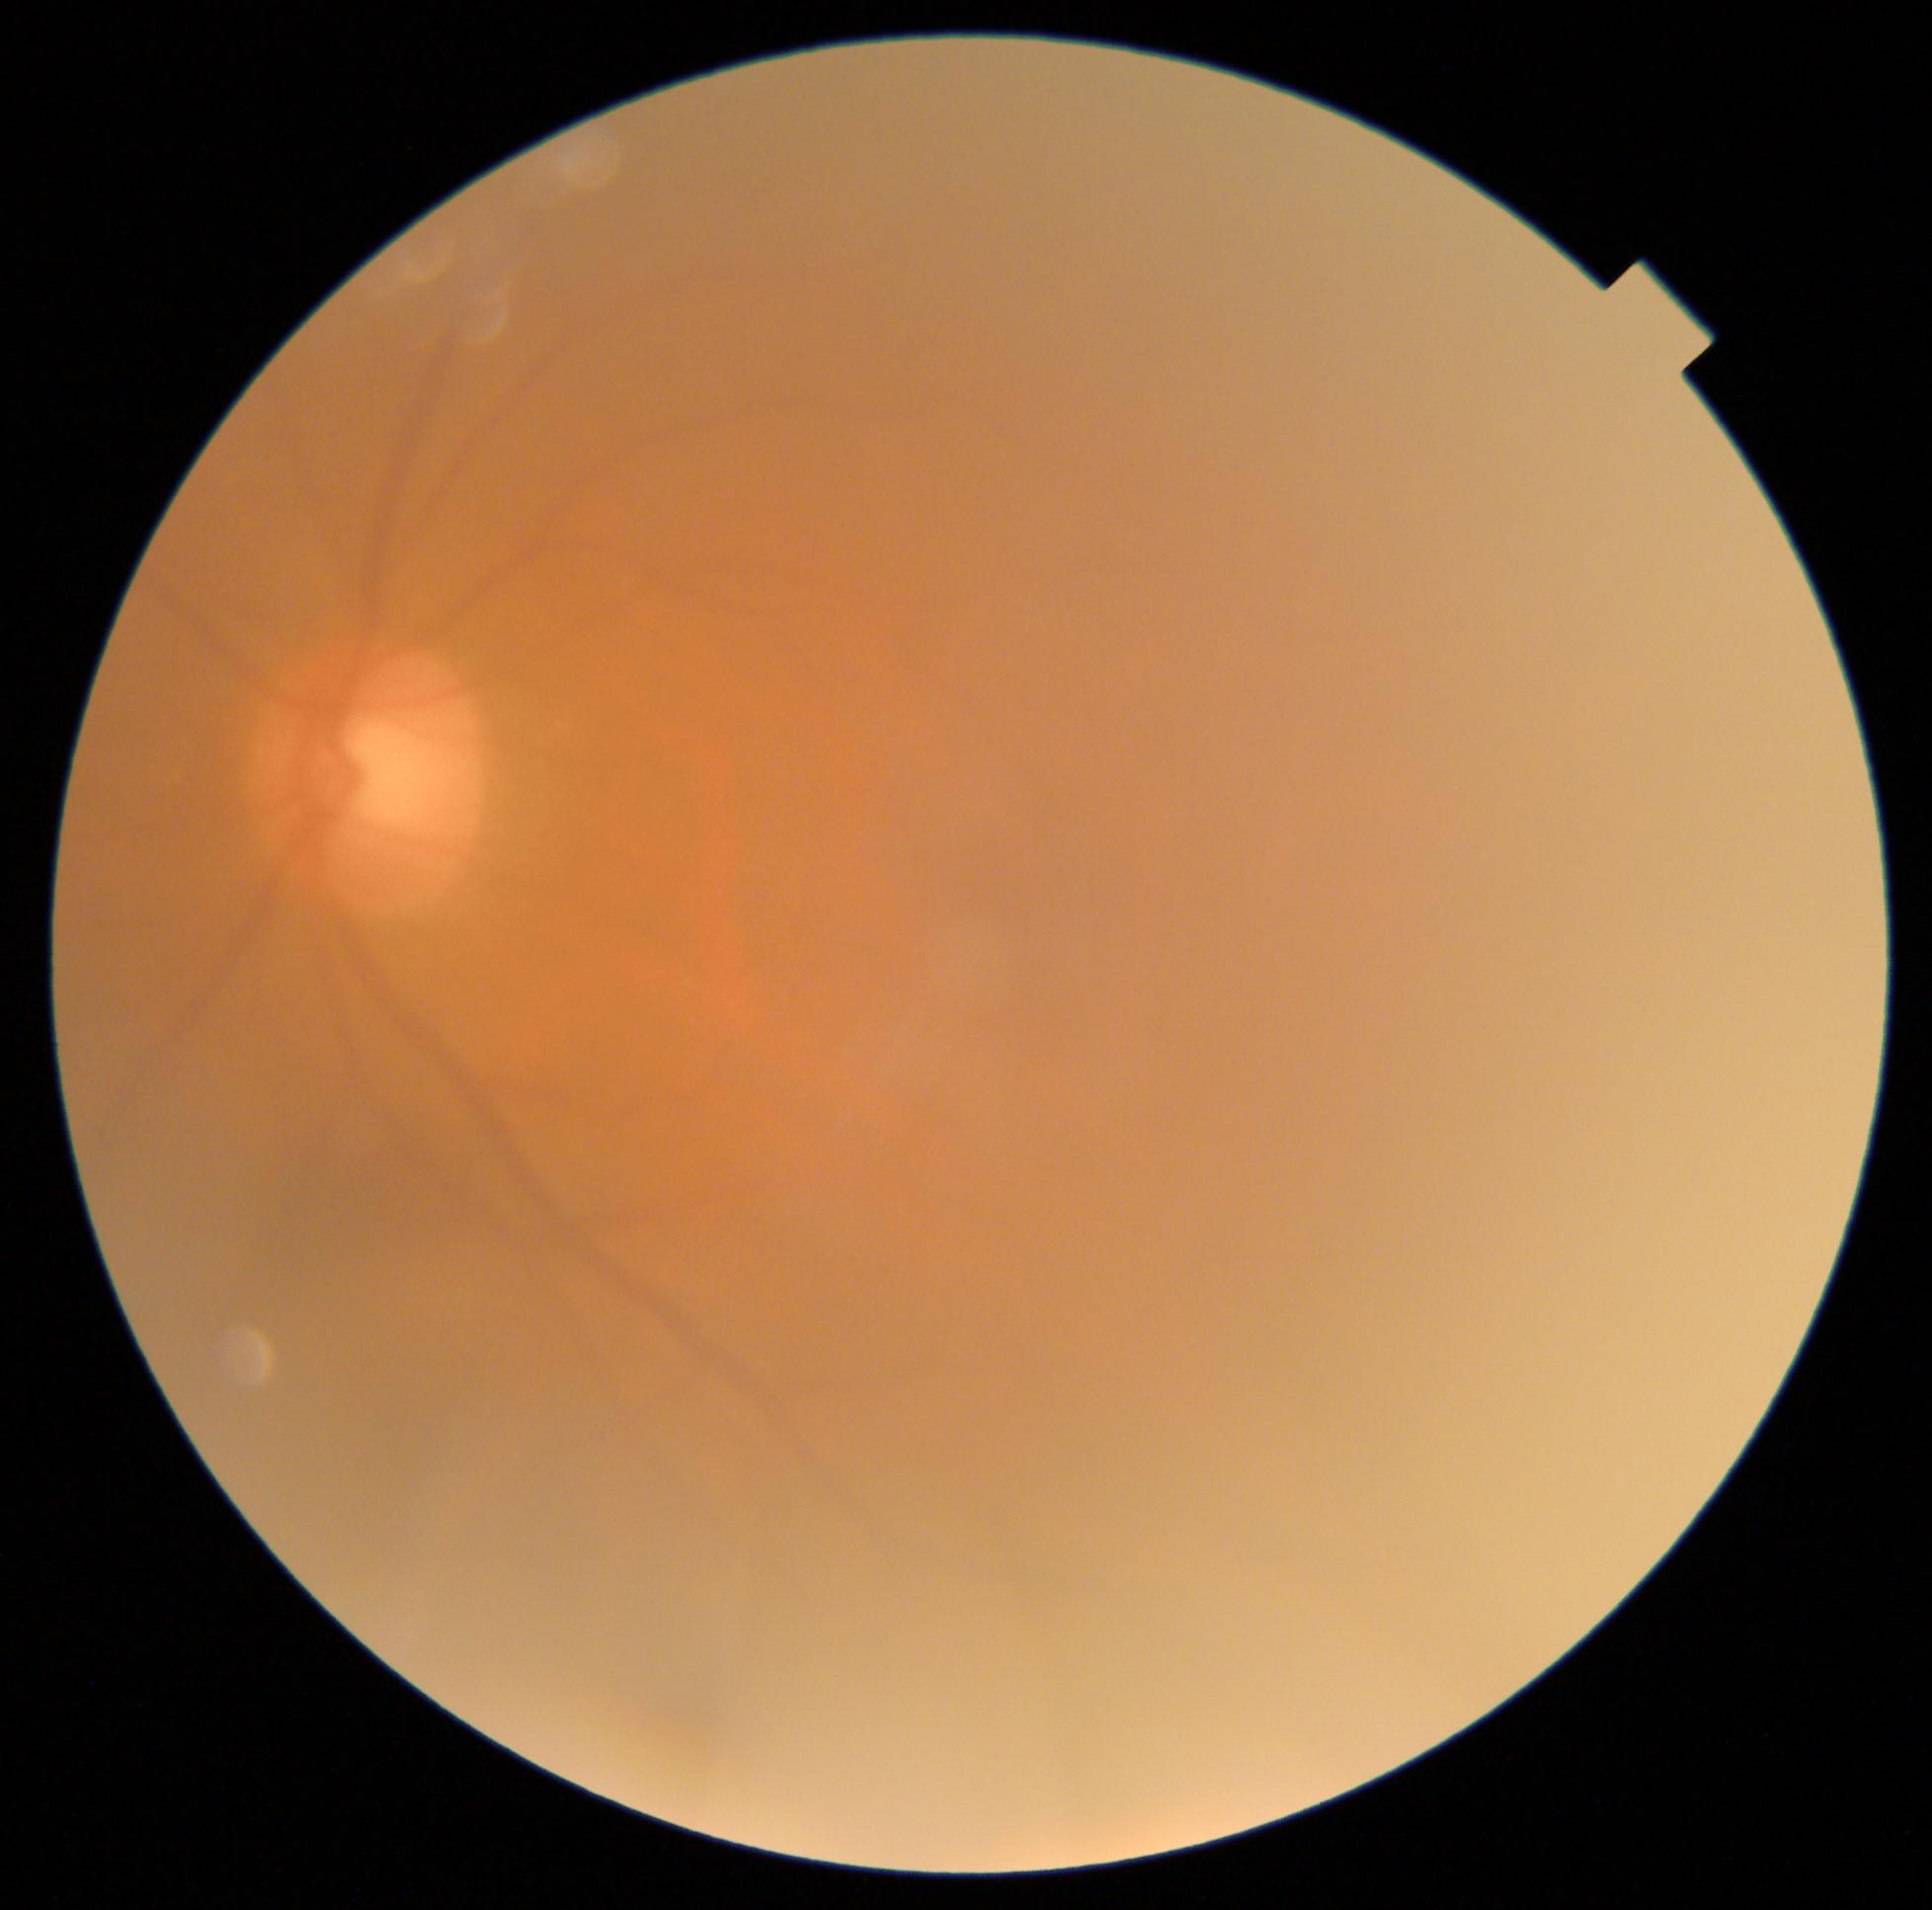 Diabetic retinopathy (DR): grade 0 (no apparent retinopathy).